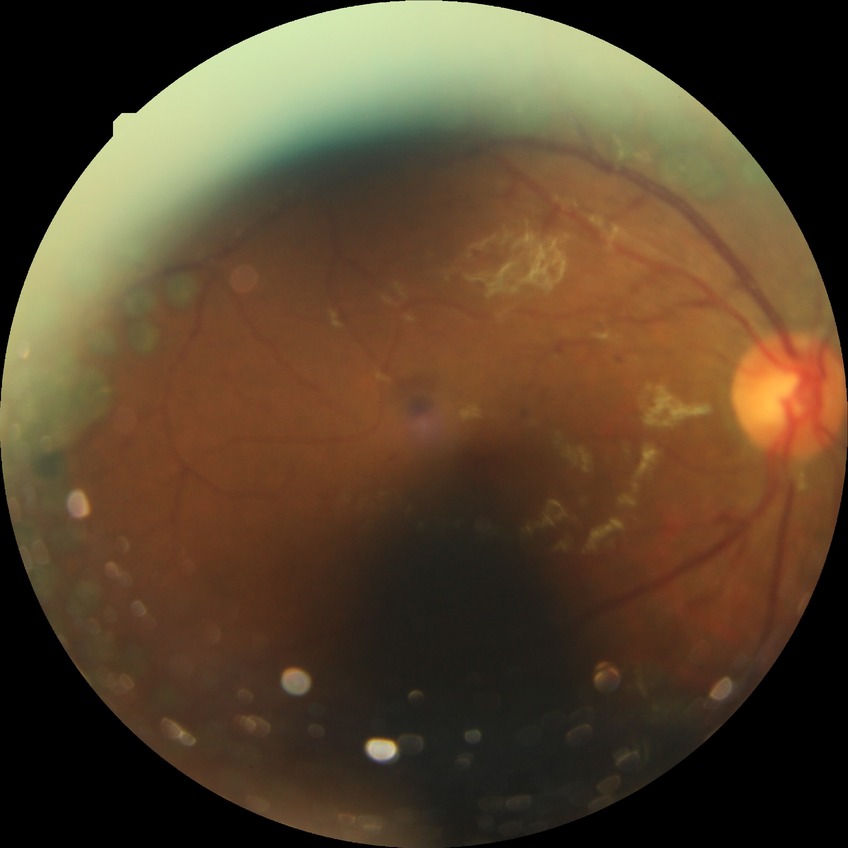 DR stage = PDR.